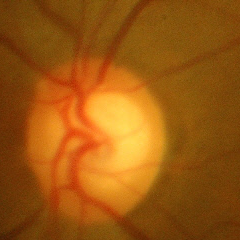 No glaucomatous optic neuropathy.